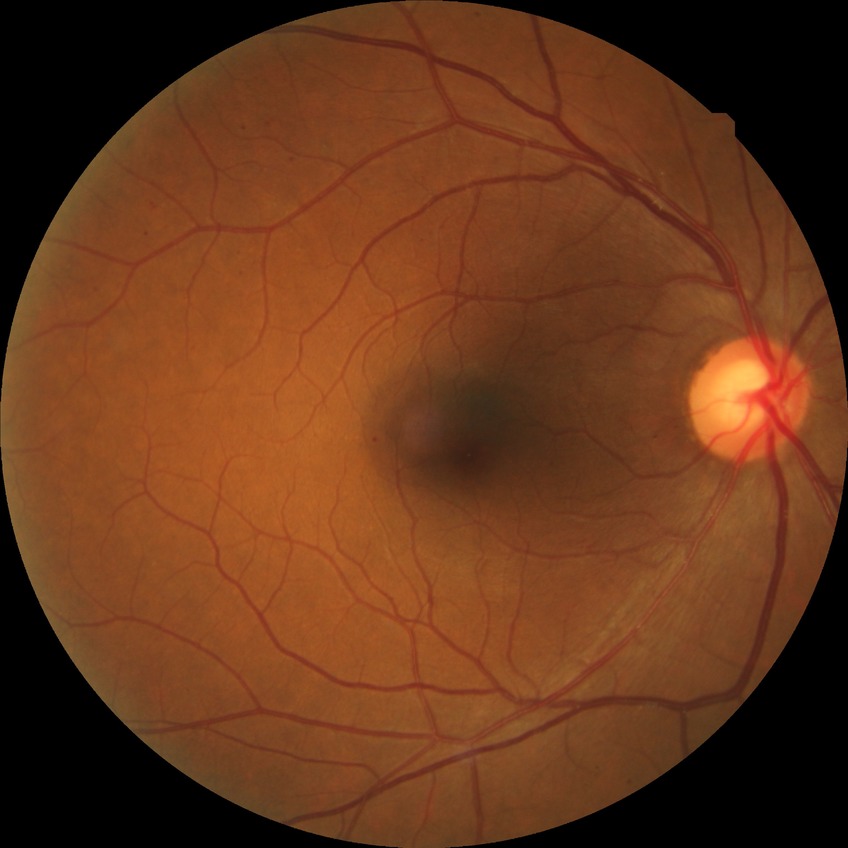
Annotations:
* diabetic retinopathy (DR) — simple diabetic retinopathy (SDR)